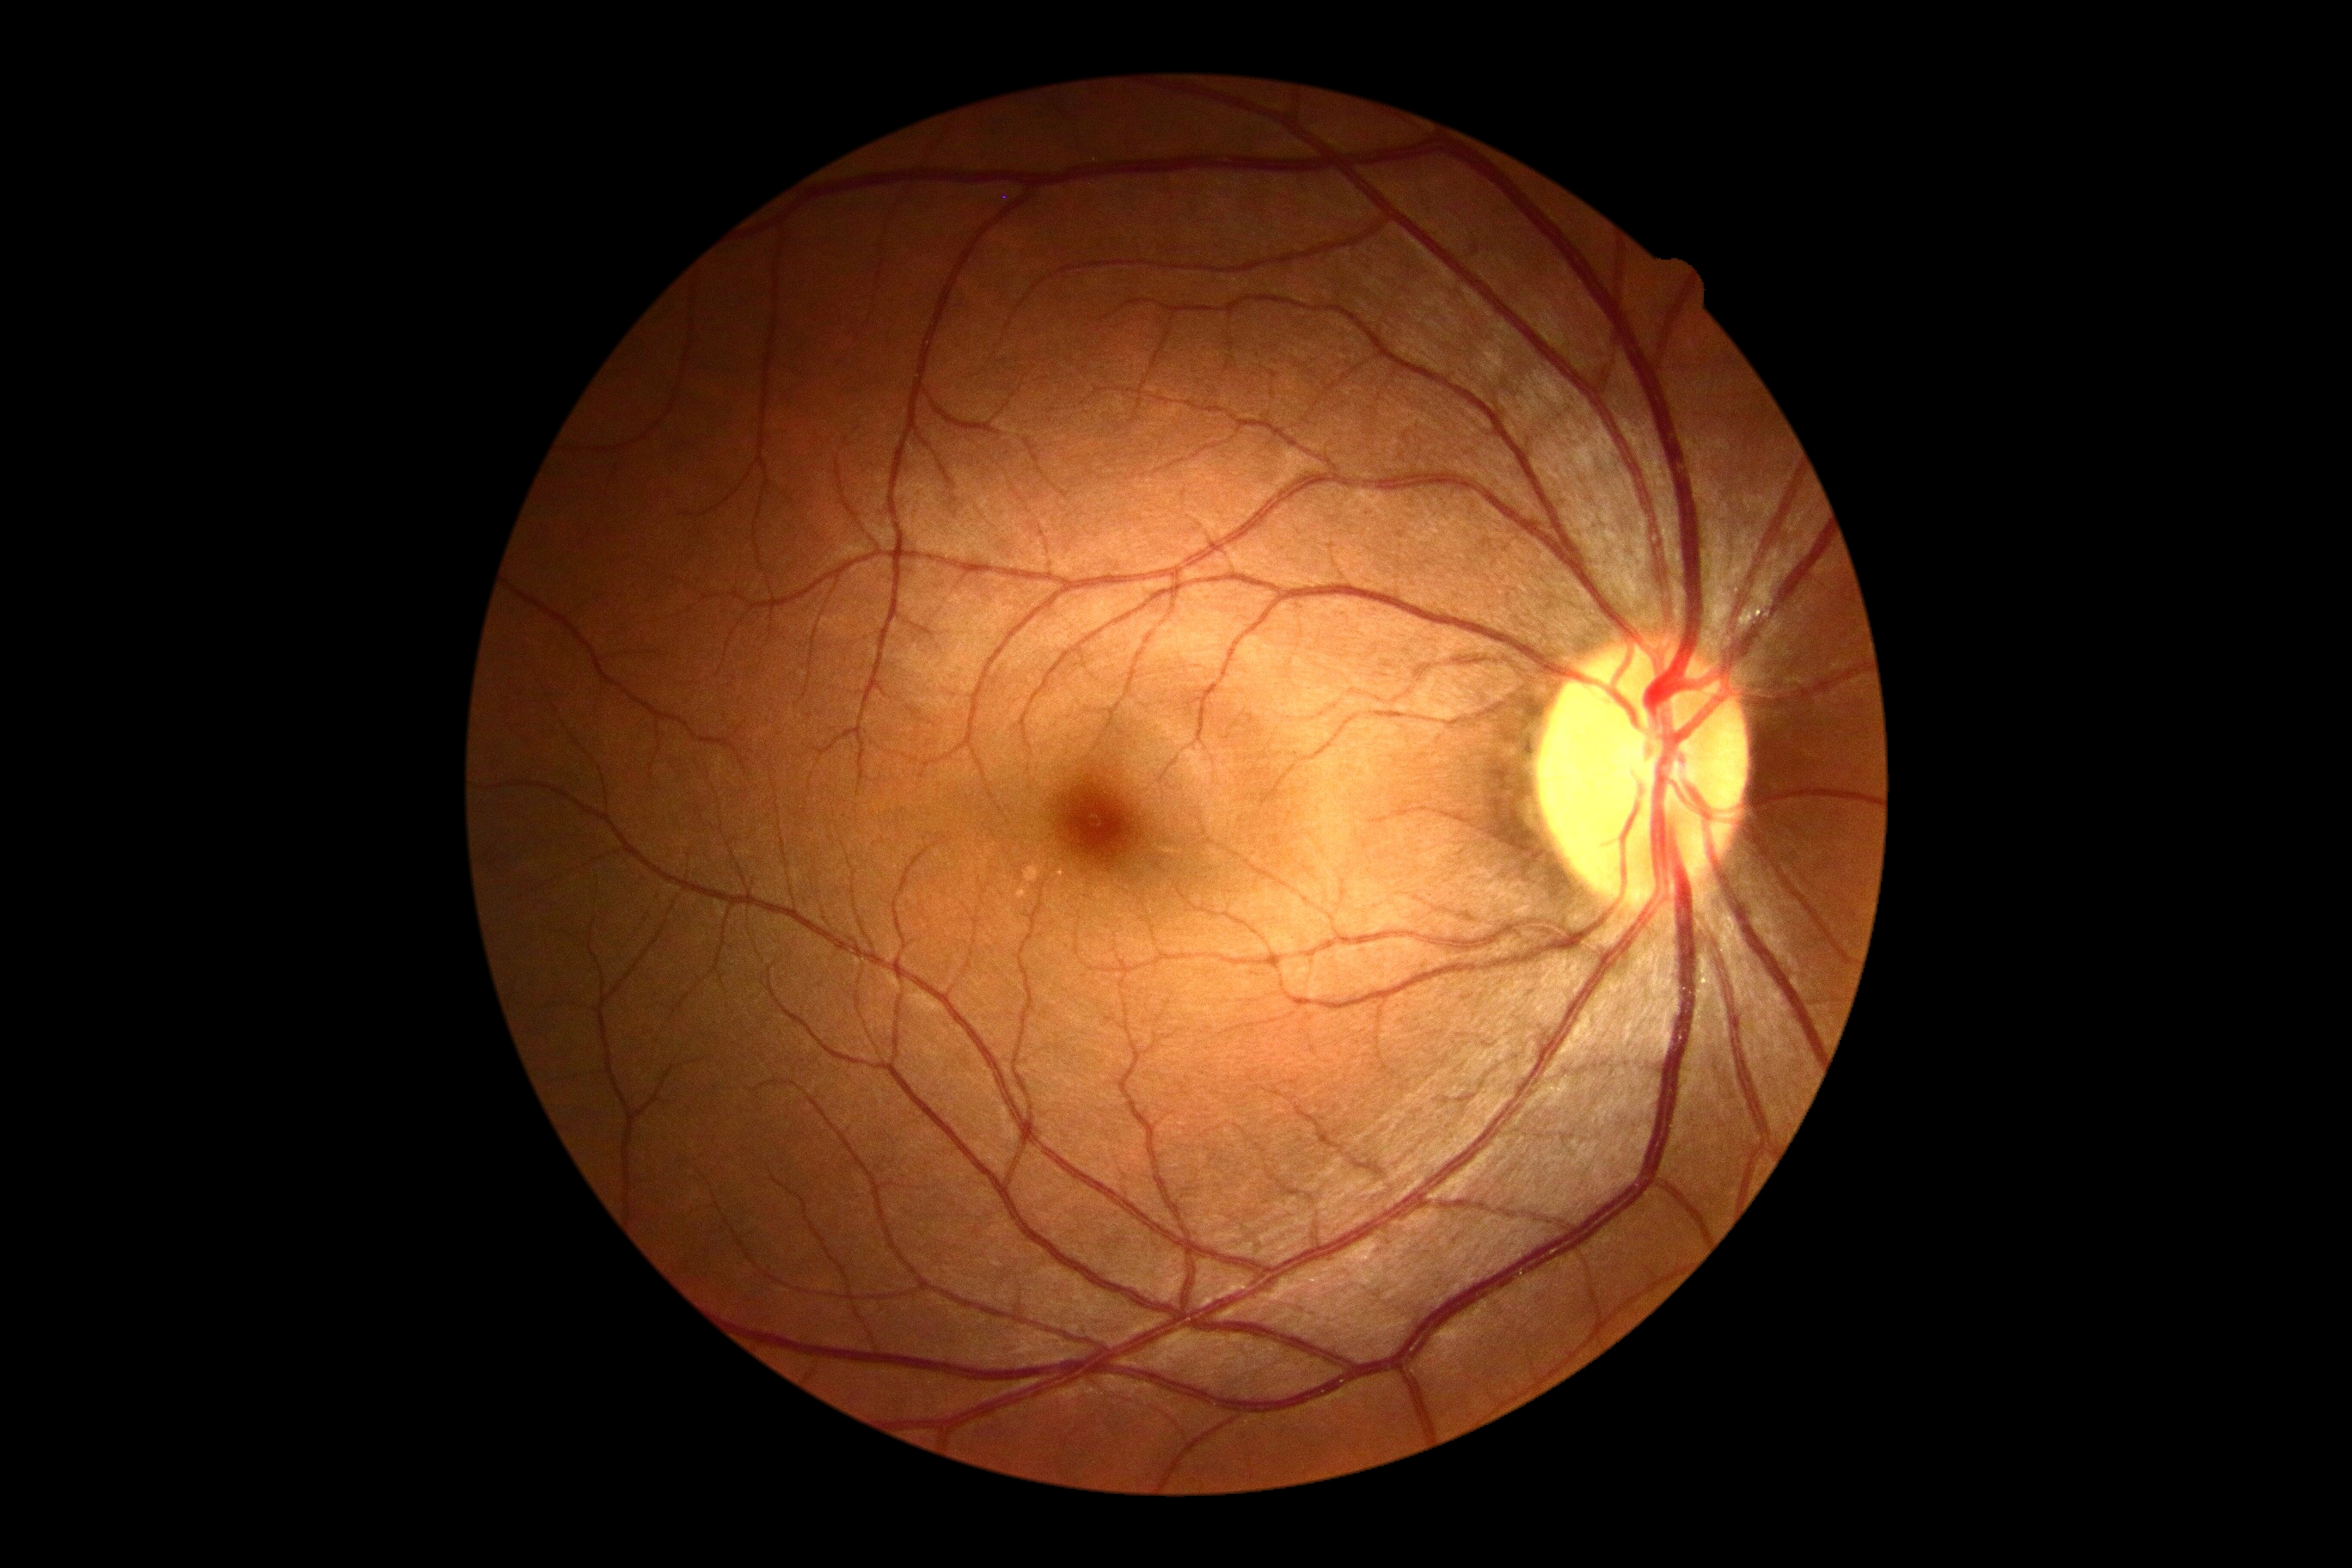
DR: no apparent retinopathy (grade 0)